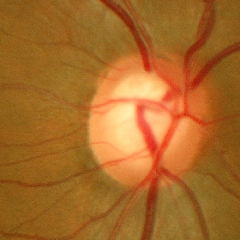 Findings consistent with glaucoma. Assessment = early glaucomatous changes.